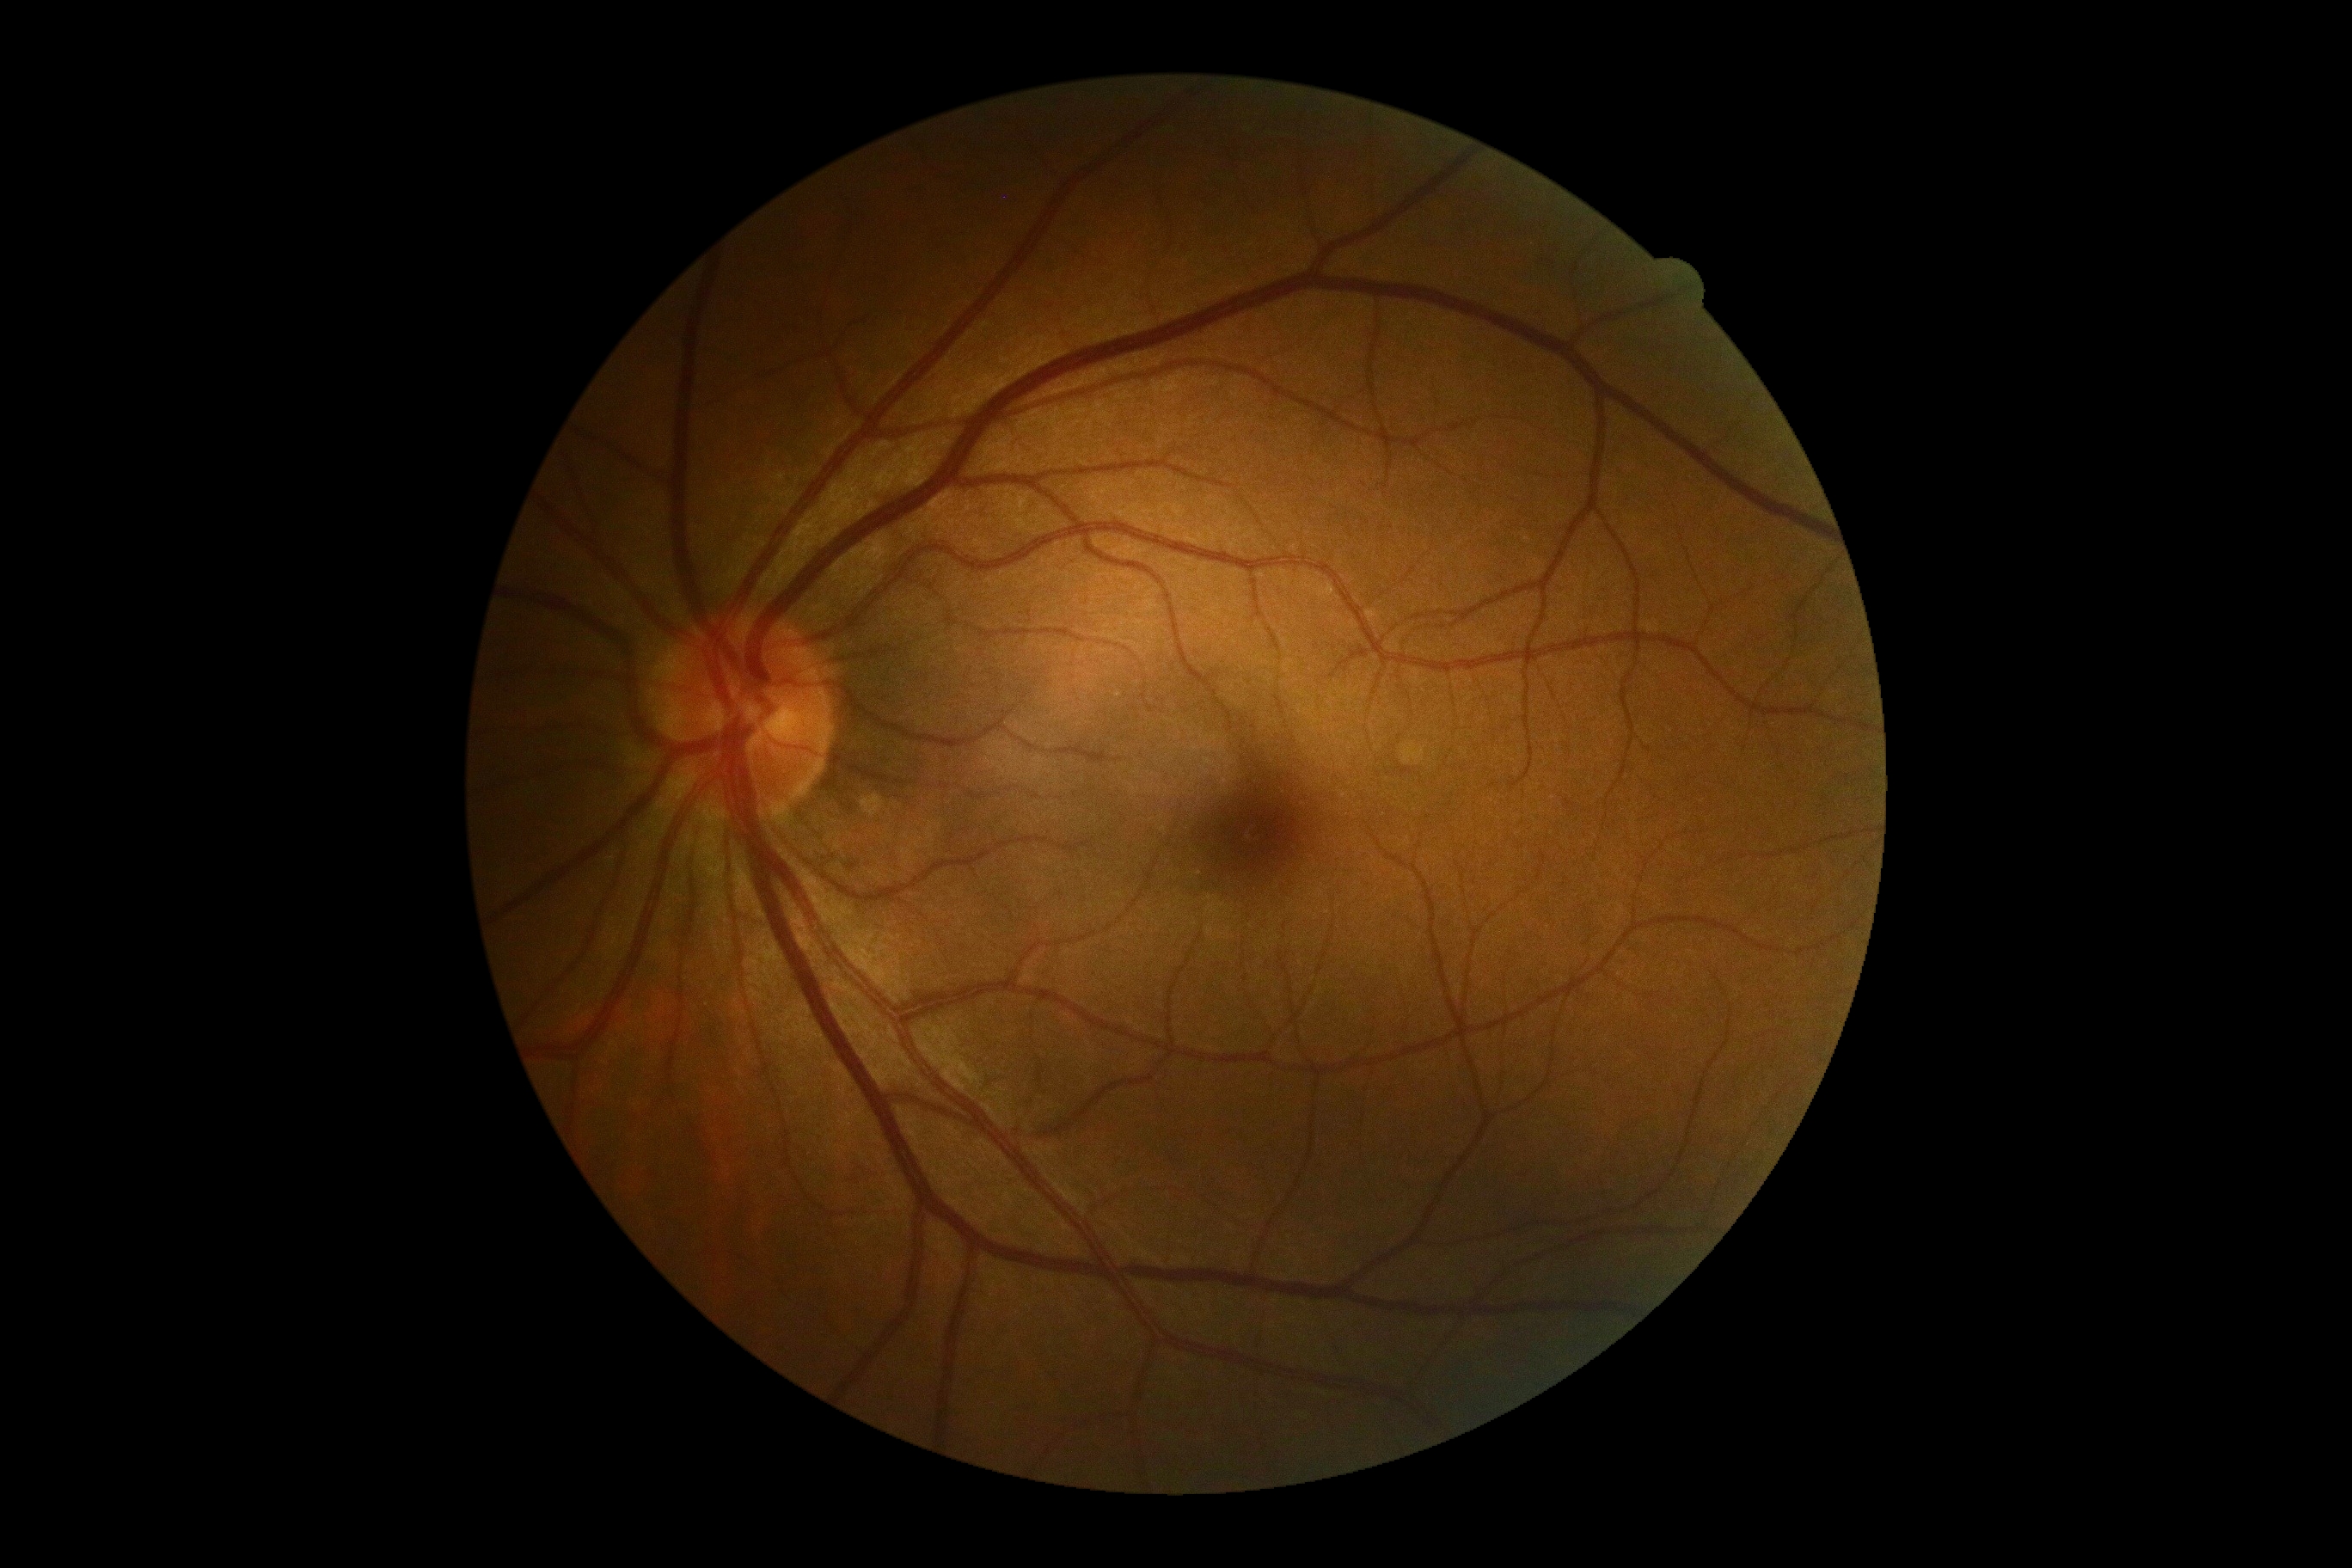 DR is no apparent diabetic retinopathy (grade 0) — no visible signs of diabetic retinopathy.
No DR findings.